Color fundus image
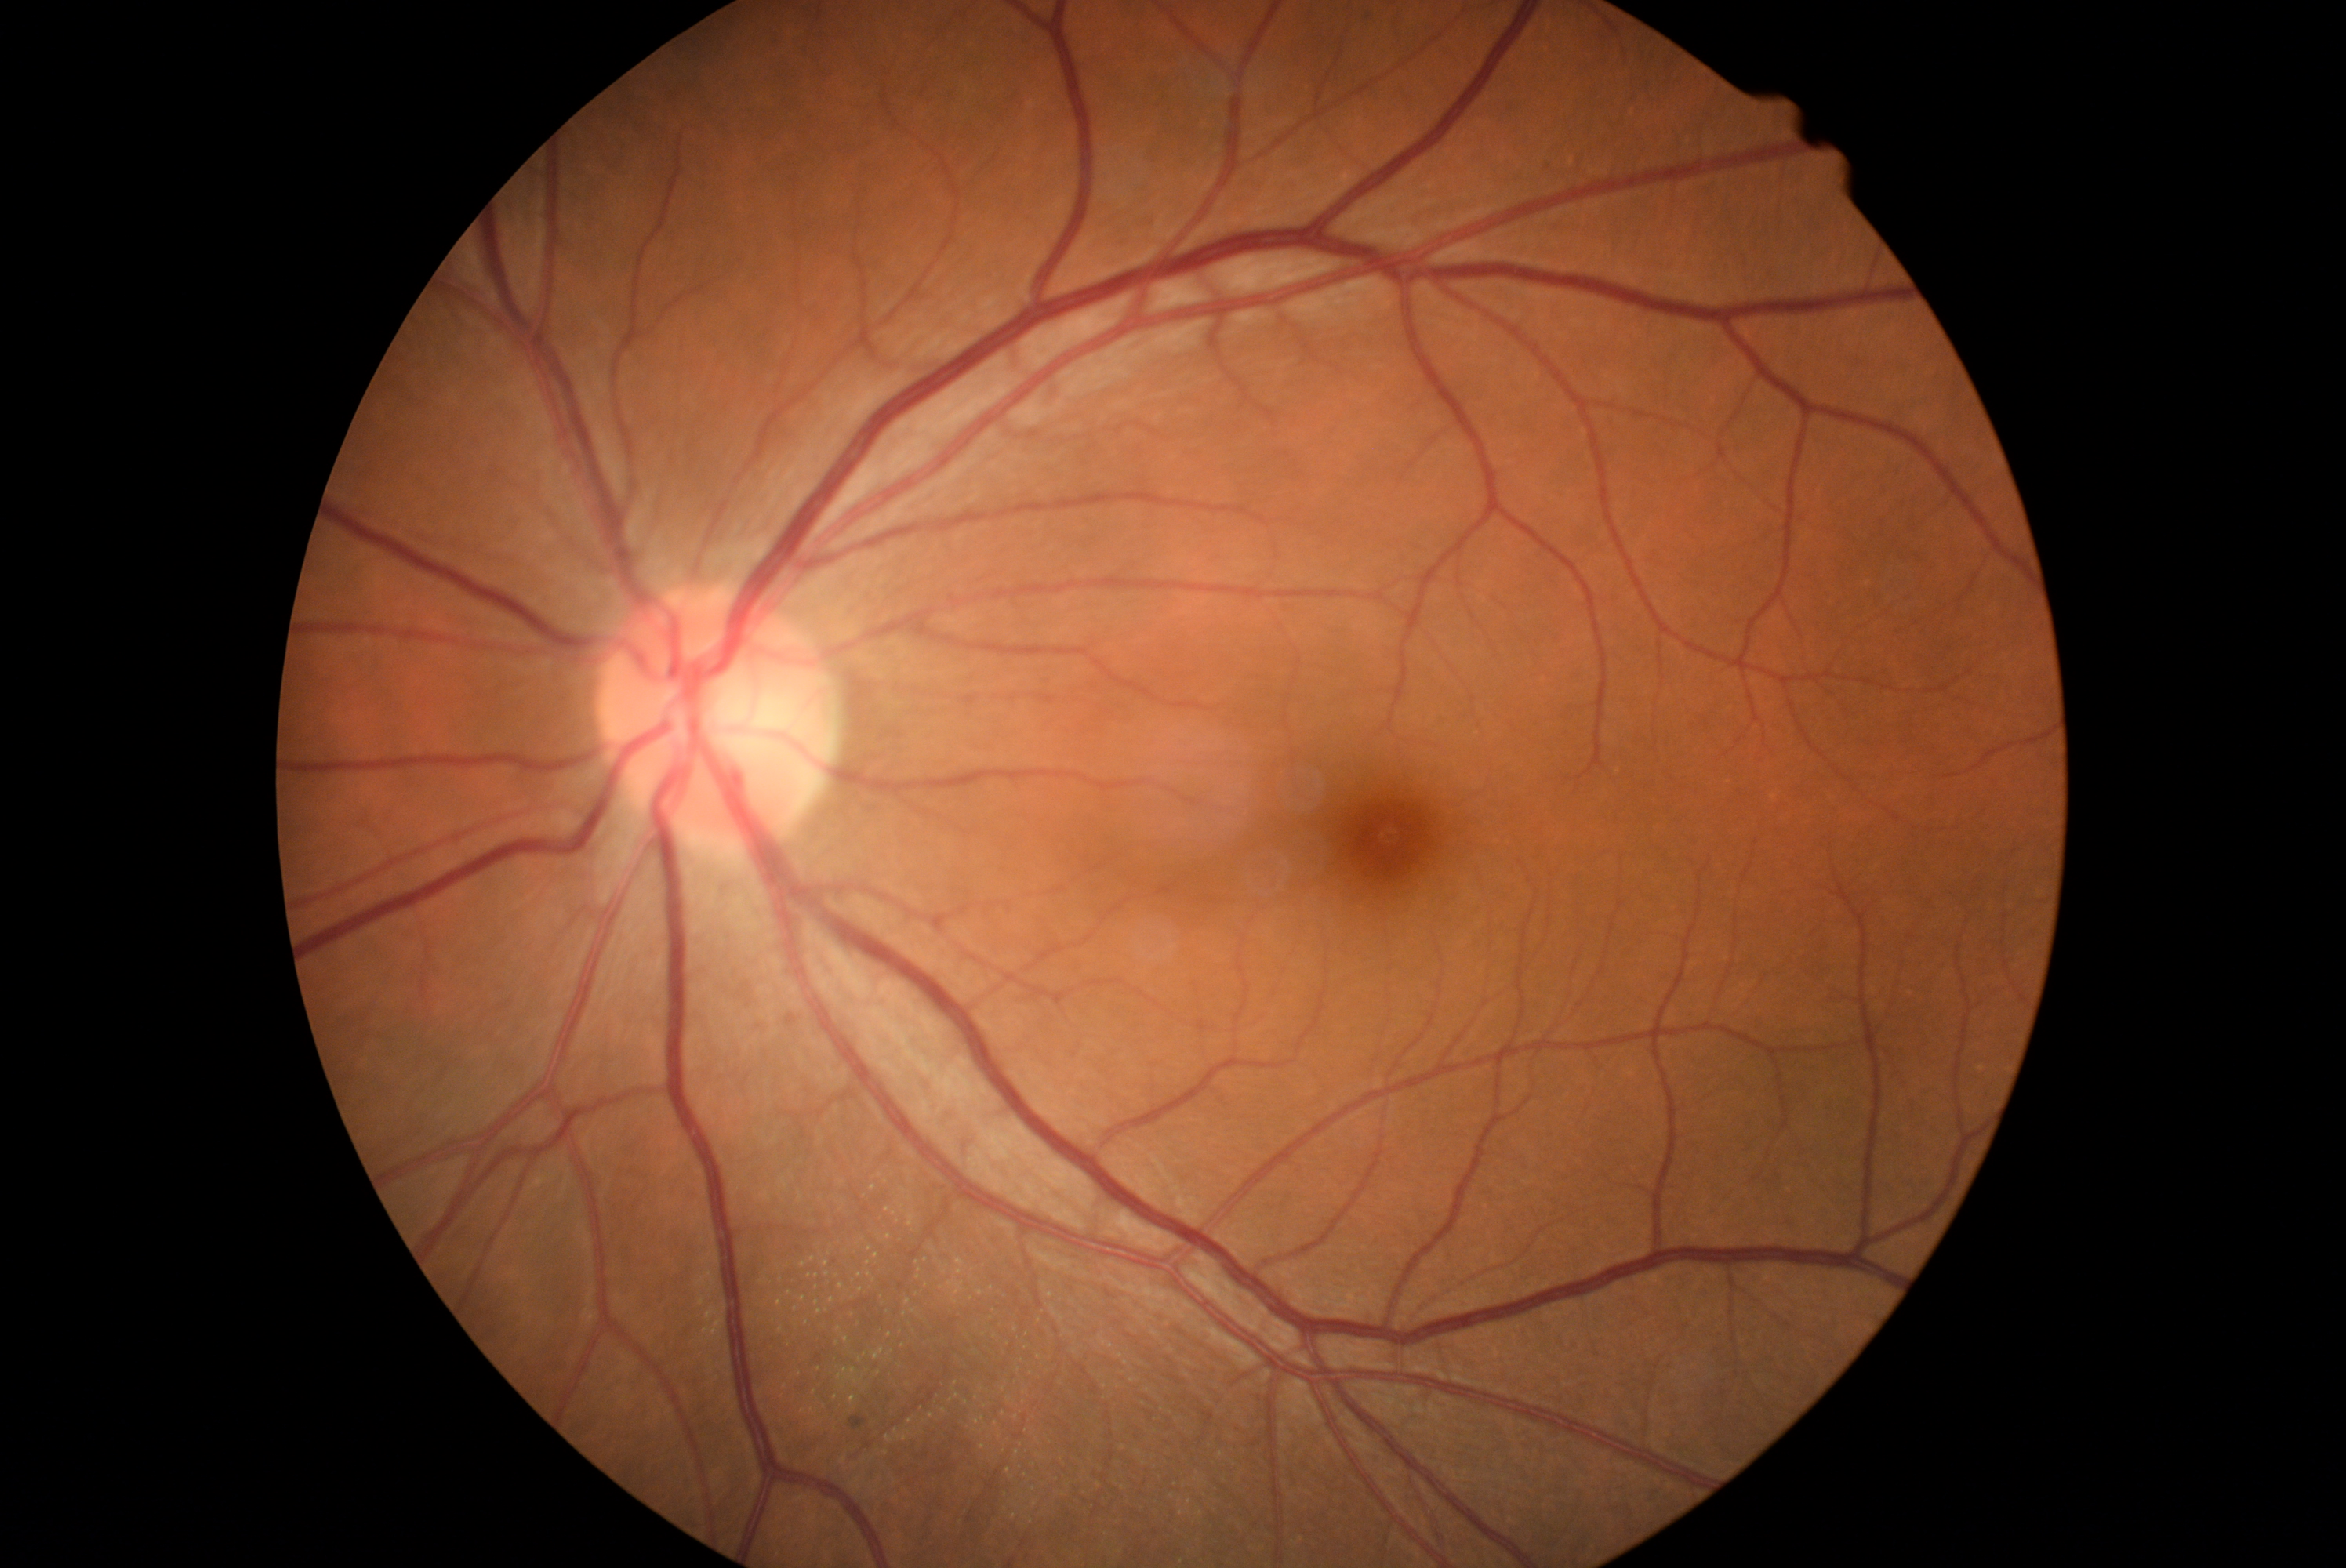
{"dr_impression": "no apparent DR", "dr_grade": "grade 0 (no apparent retinopathy)"}